2089x1764px
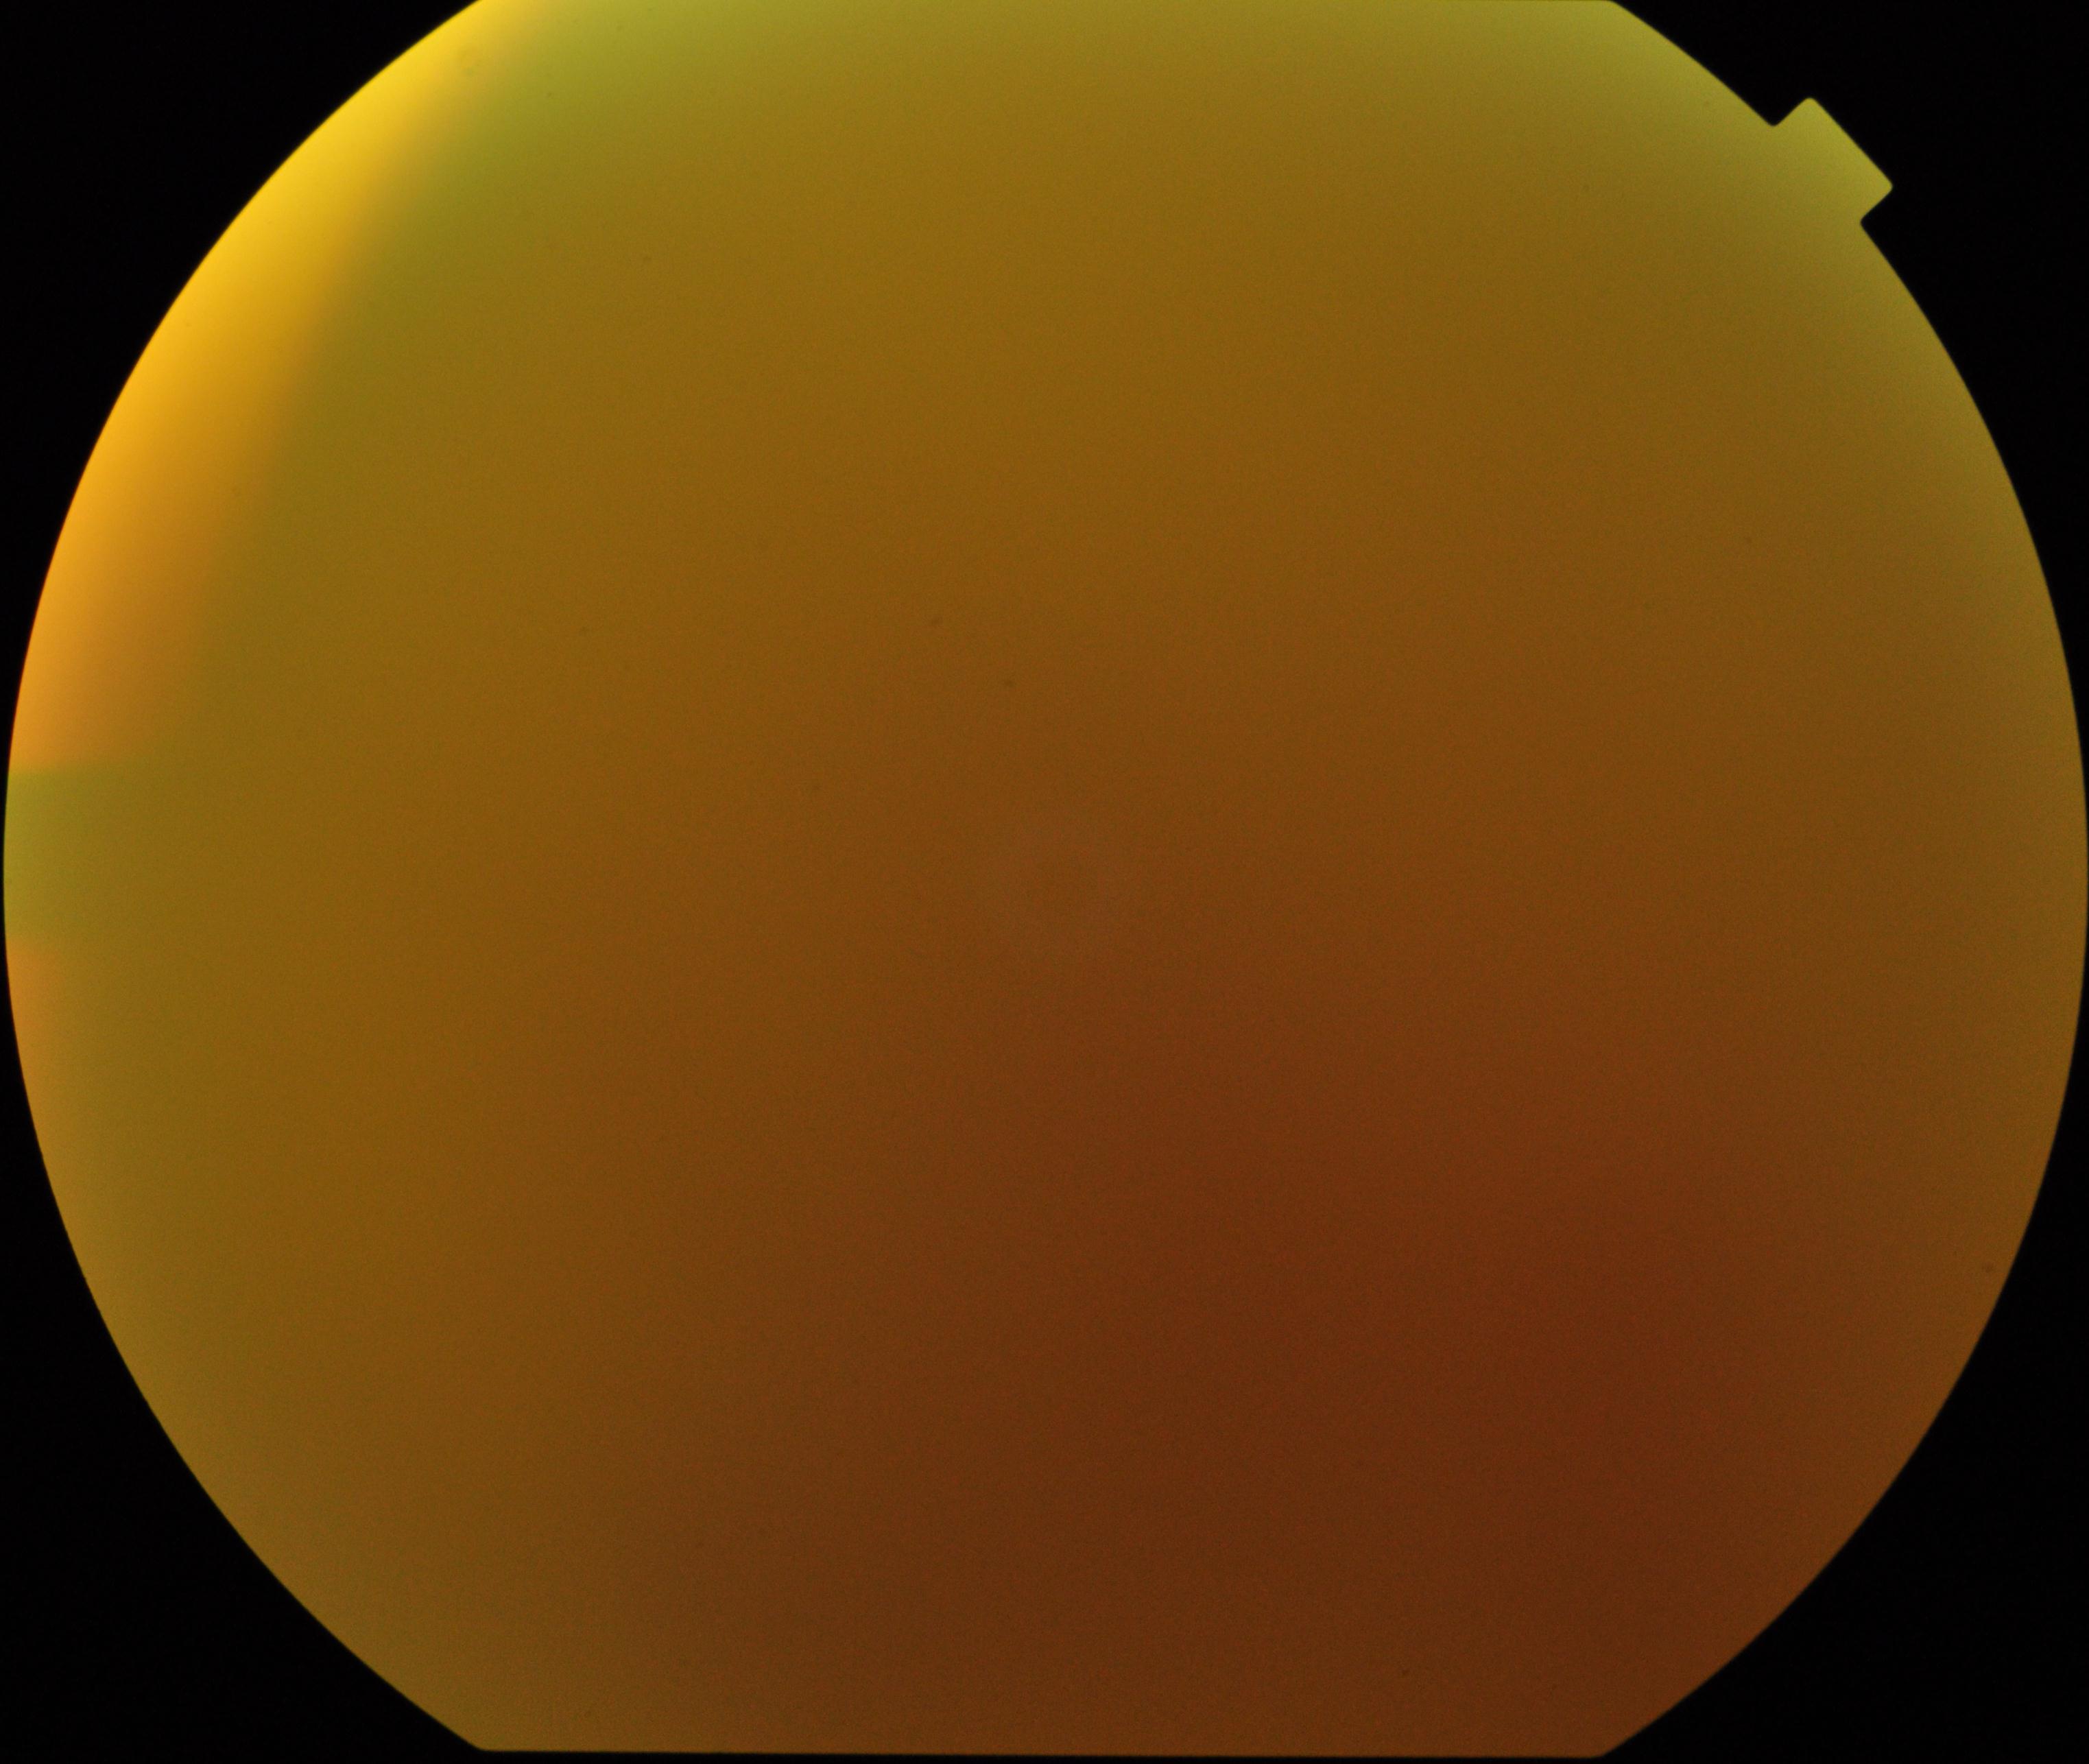 Significantly degraded image quality with obscured retinal detail. No evidence of proliferative diabetic retinopathy.